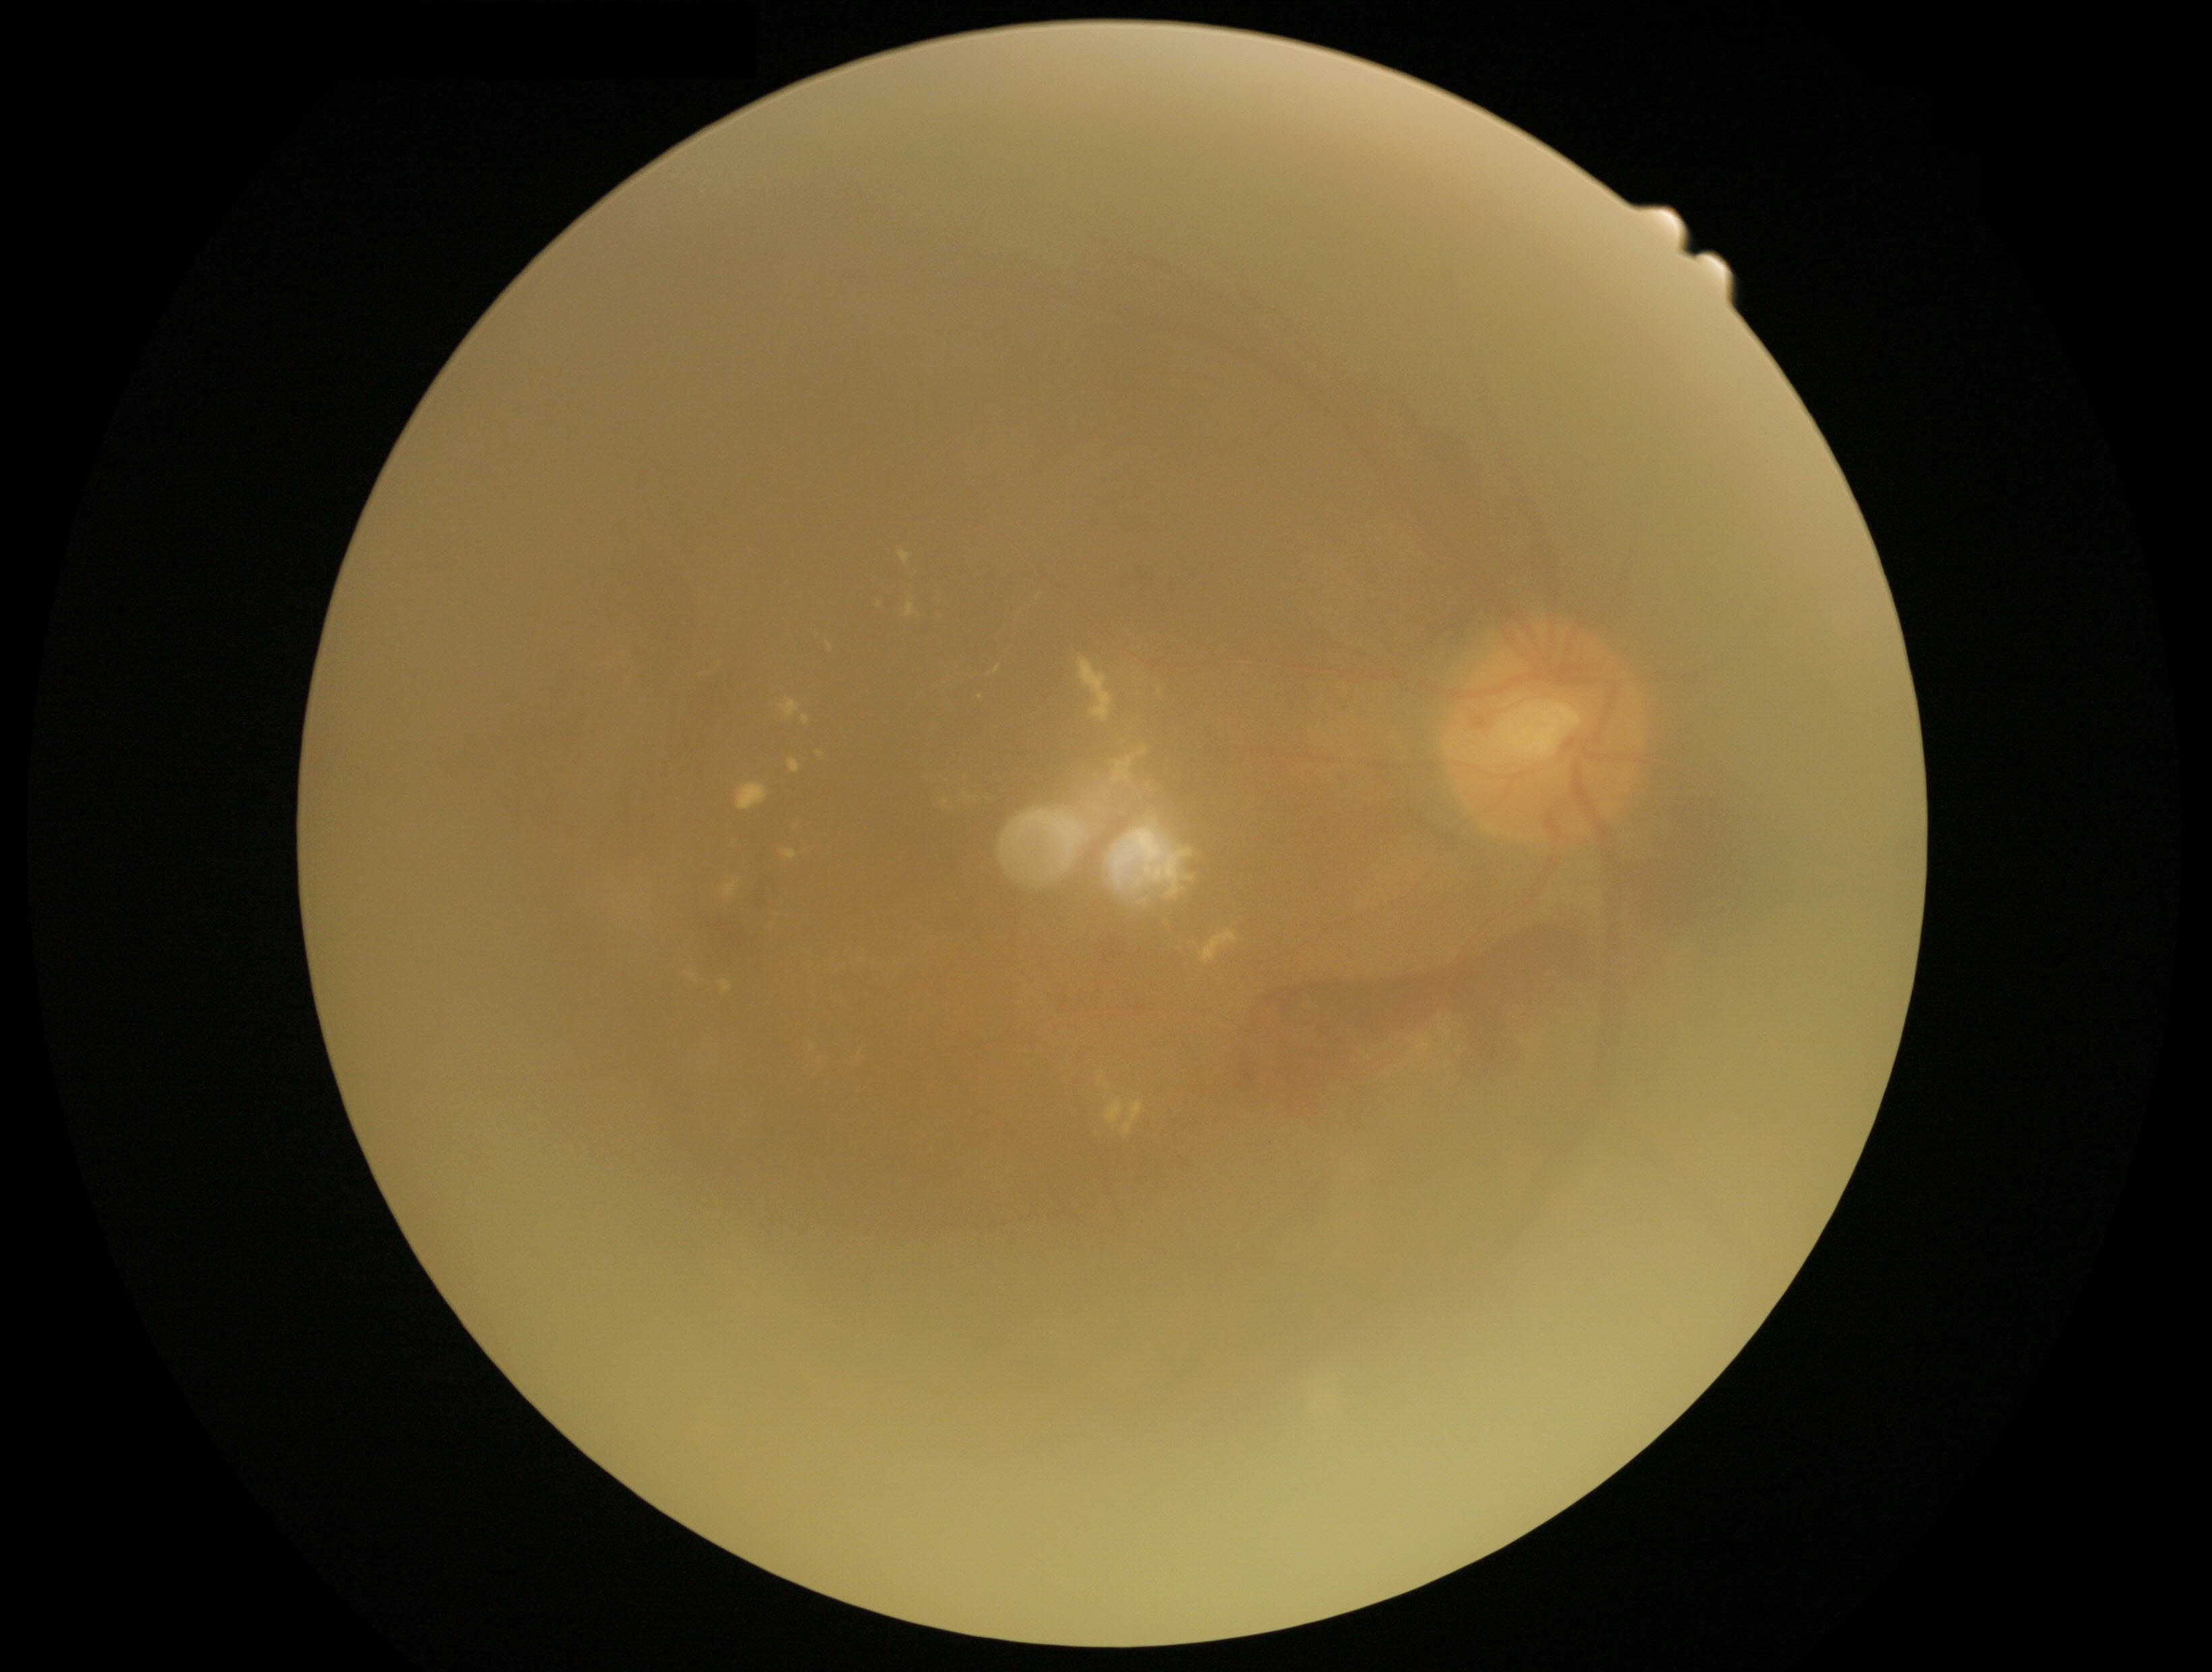 Disease class: proliferative diabetic retinopathy.
Diabetic retinopathy (DR): 4.